Image size 1380x1382. Fundus photo:
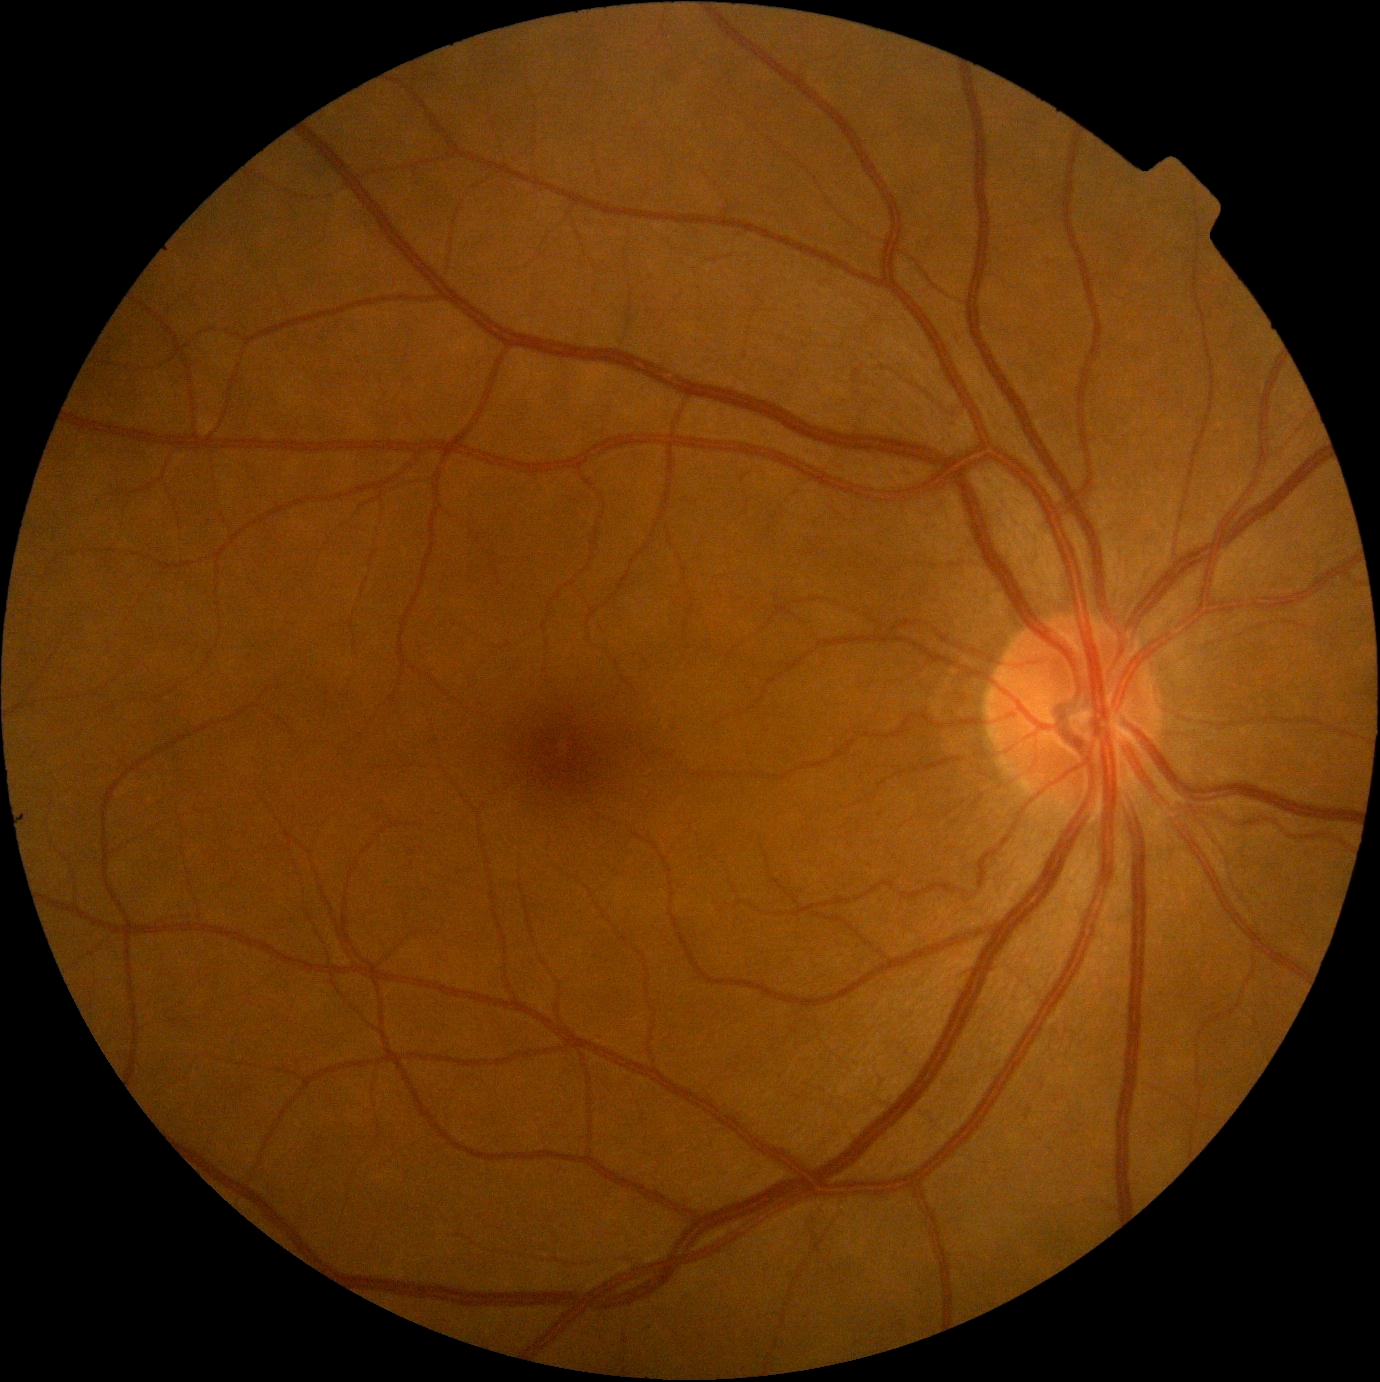

diabetic retinopathy grade = no apparent retinopathy (0) — no visible signs of diabetic retinopathy